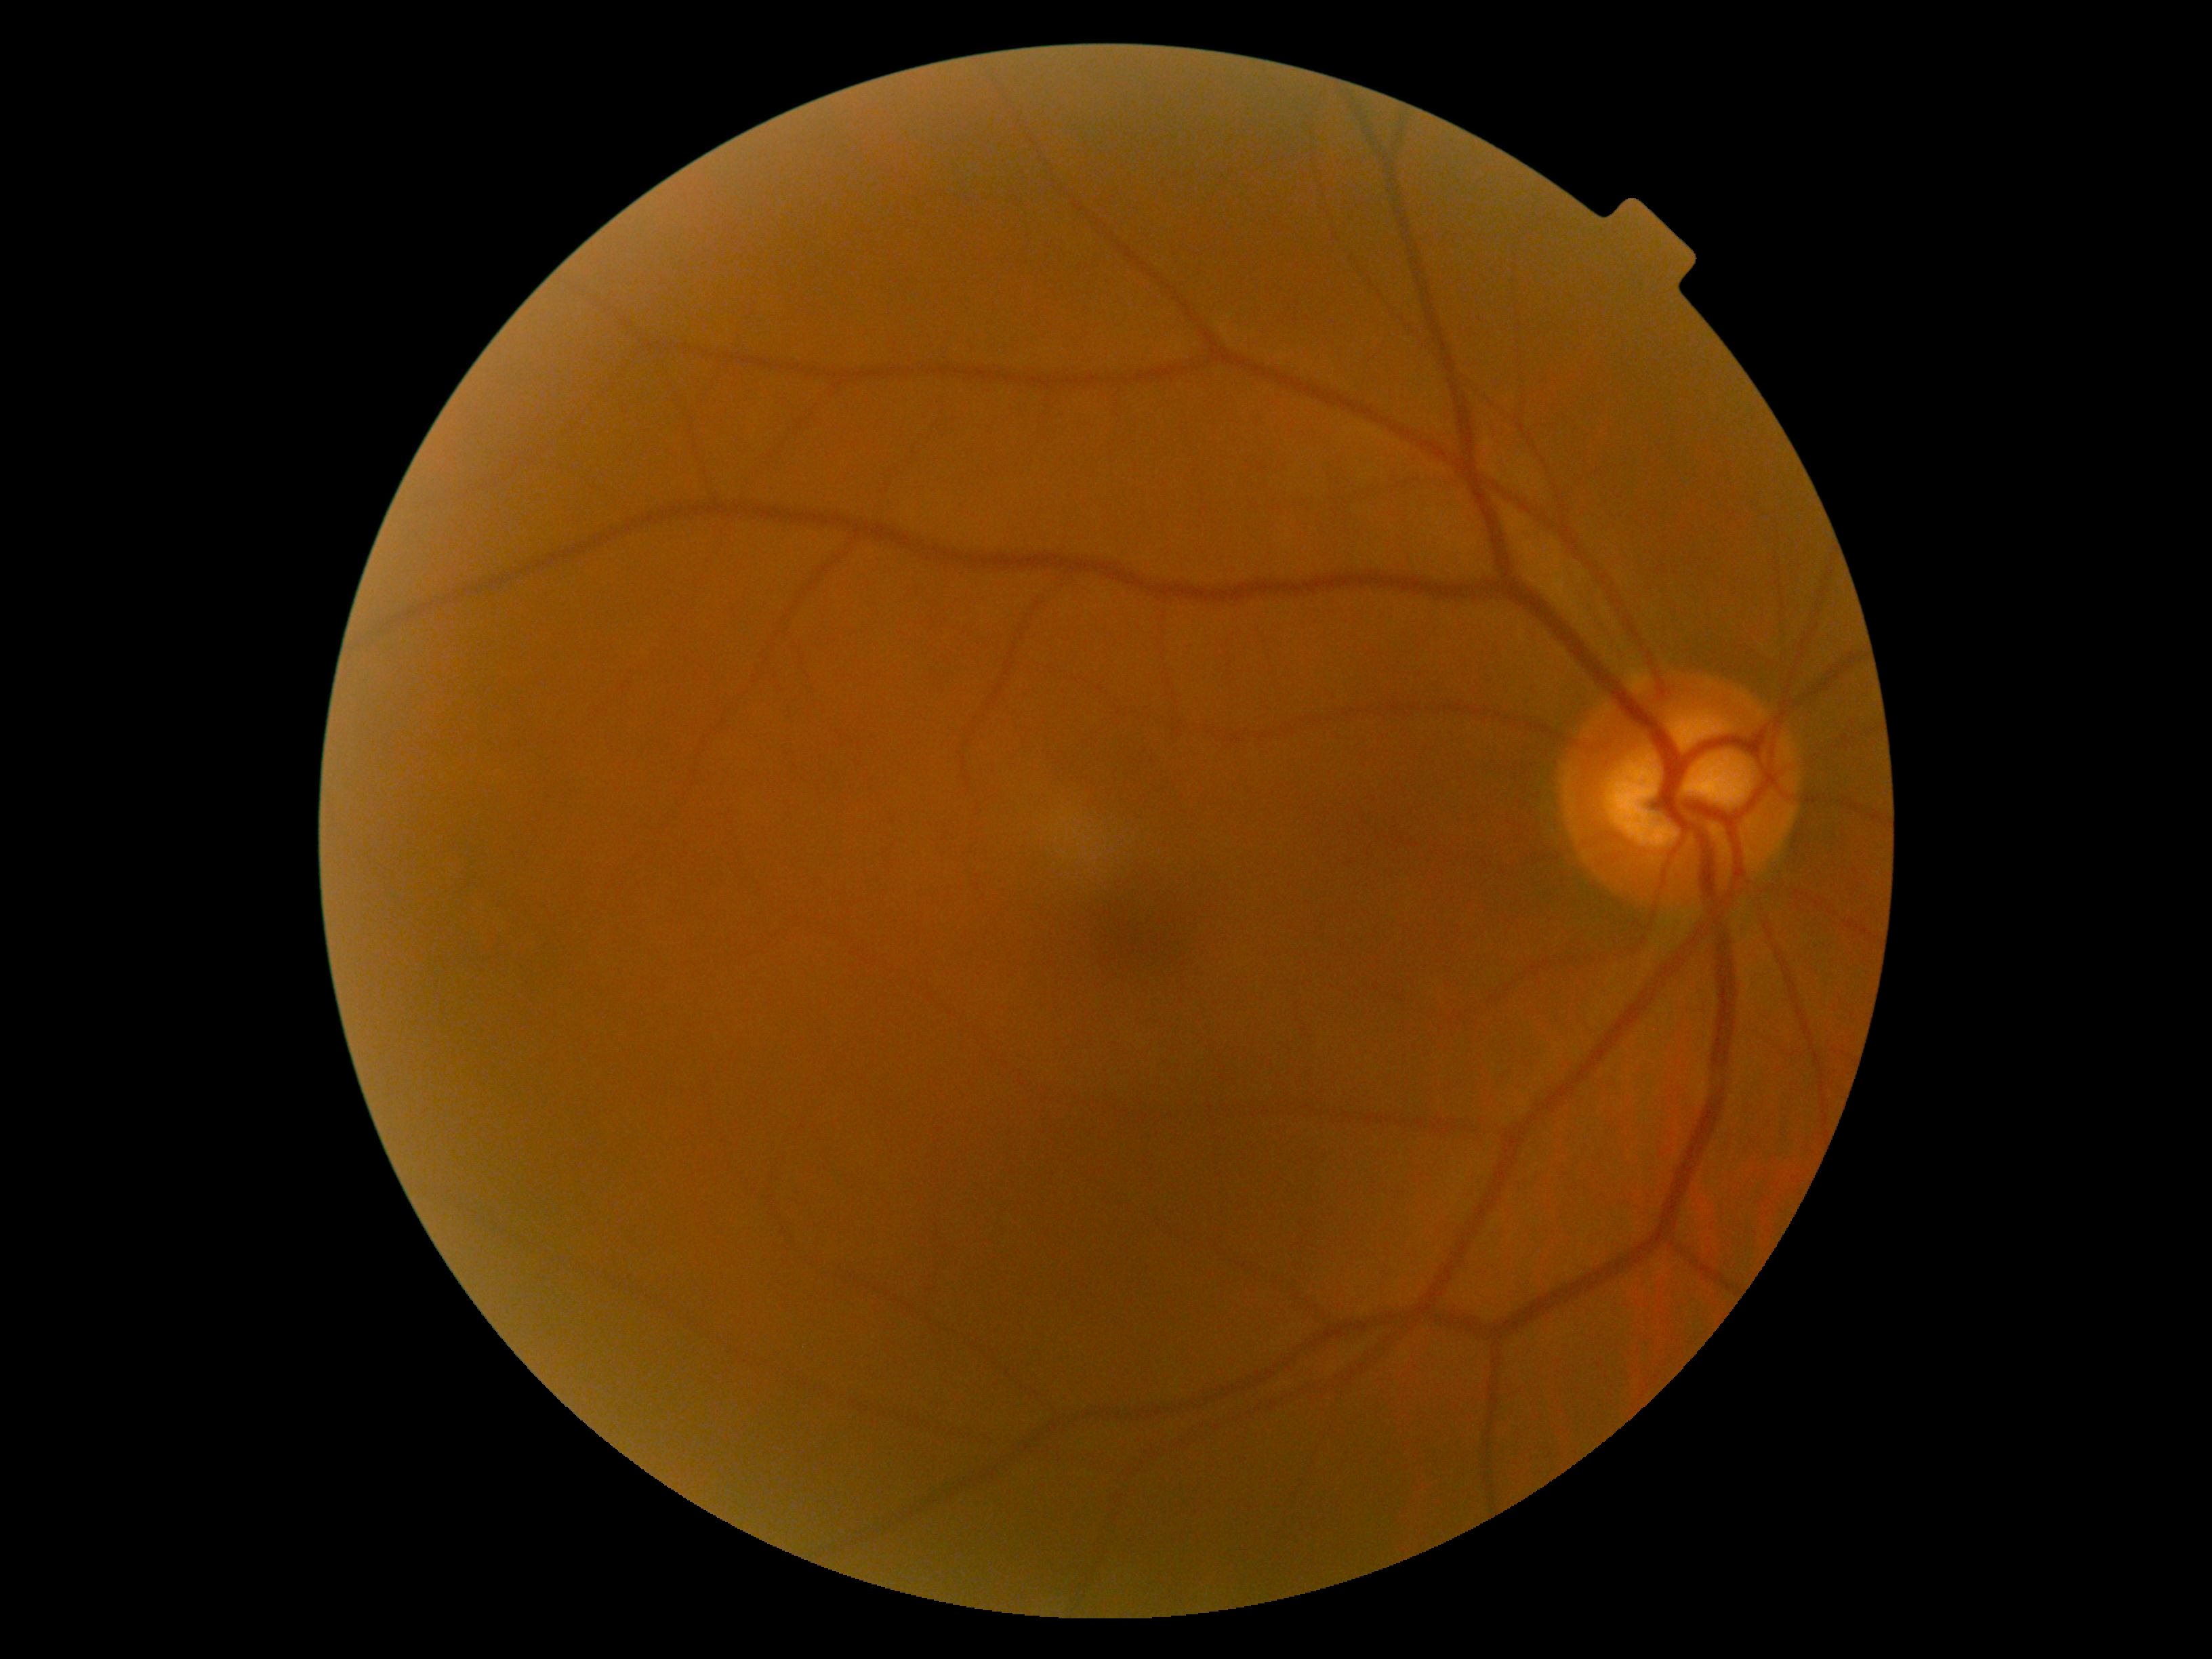

DR grade is 0 — no visible signs of diabetic retinopathy.